Color fundus photograph.
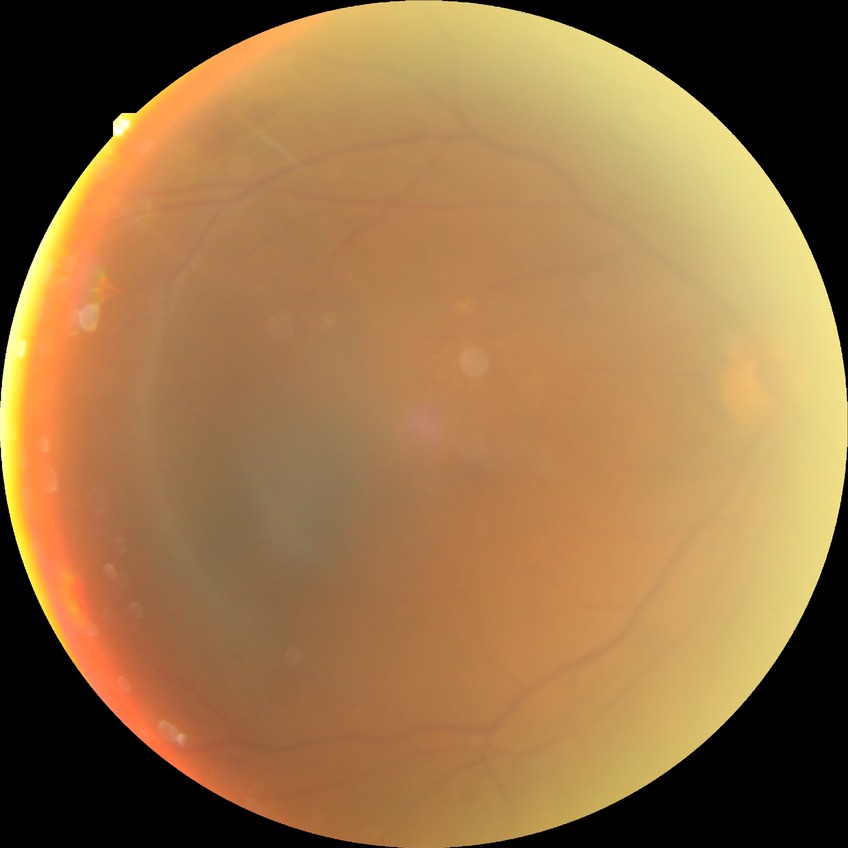
DR class: non-proliferative diabetic retinopathy. Davis grading is simple diabetic retinopathy.